Phoenix ICON wide-field infant fundus image:
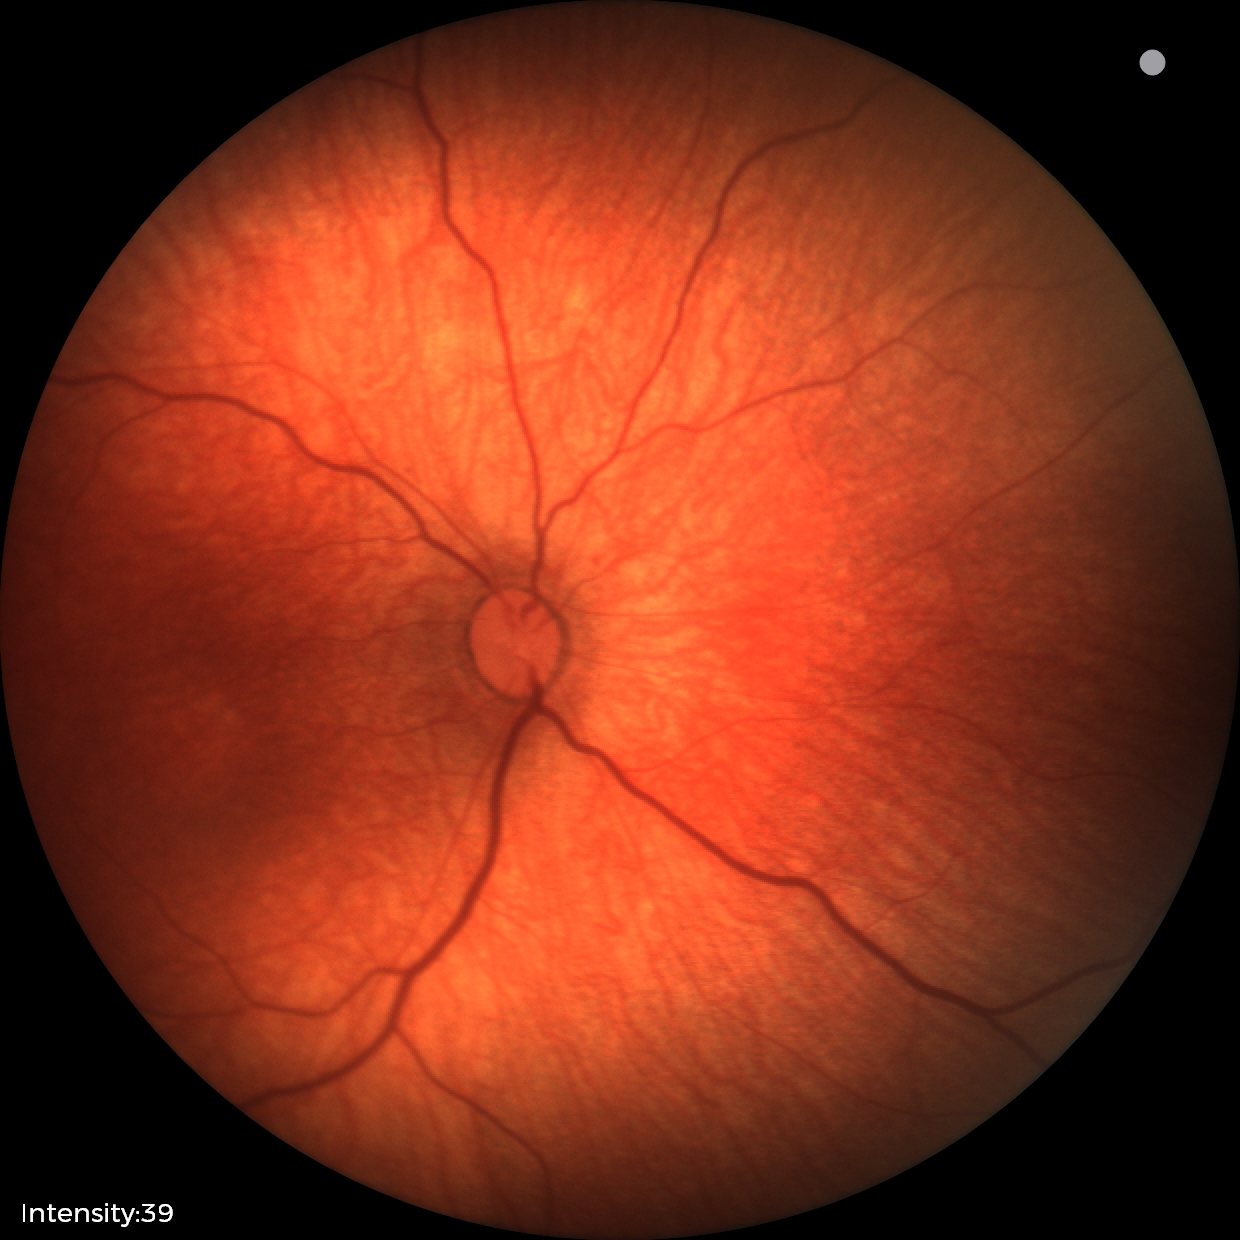
Examination with physiological retinal findings.